45-degree field of view. 2352 by 1568 pixels — 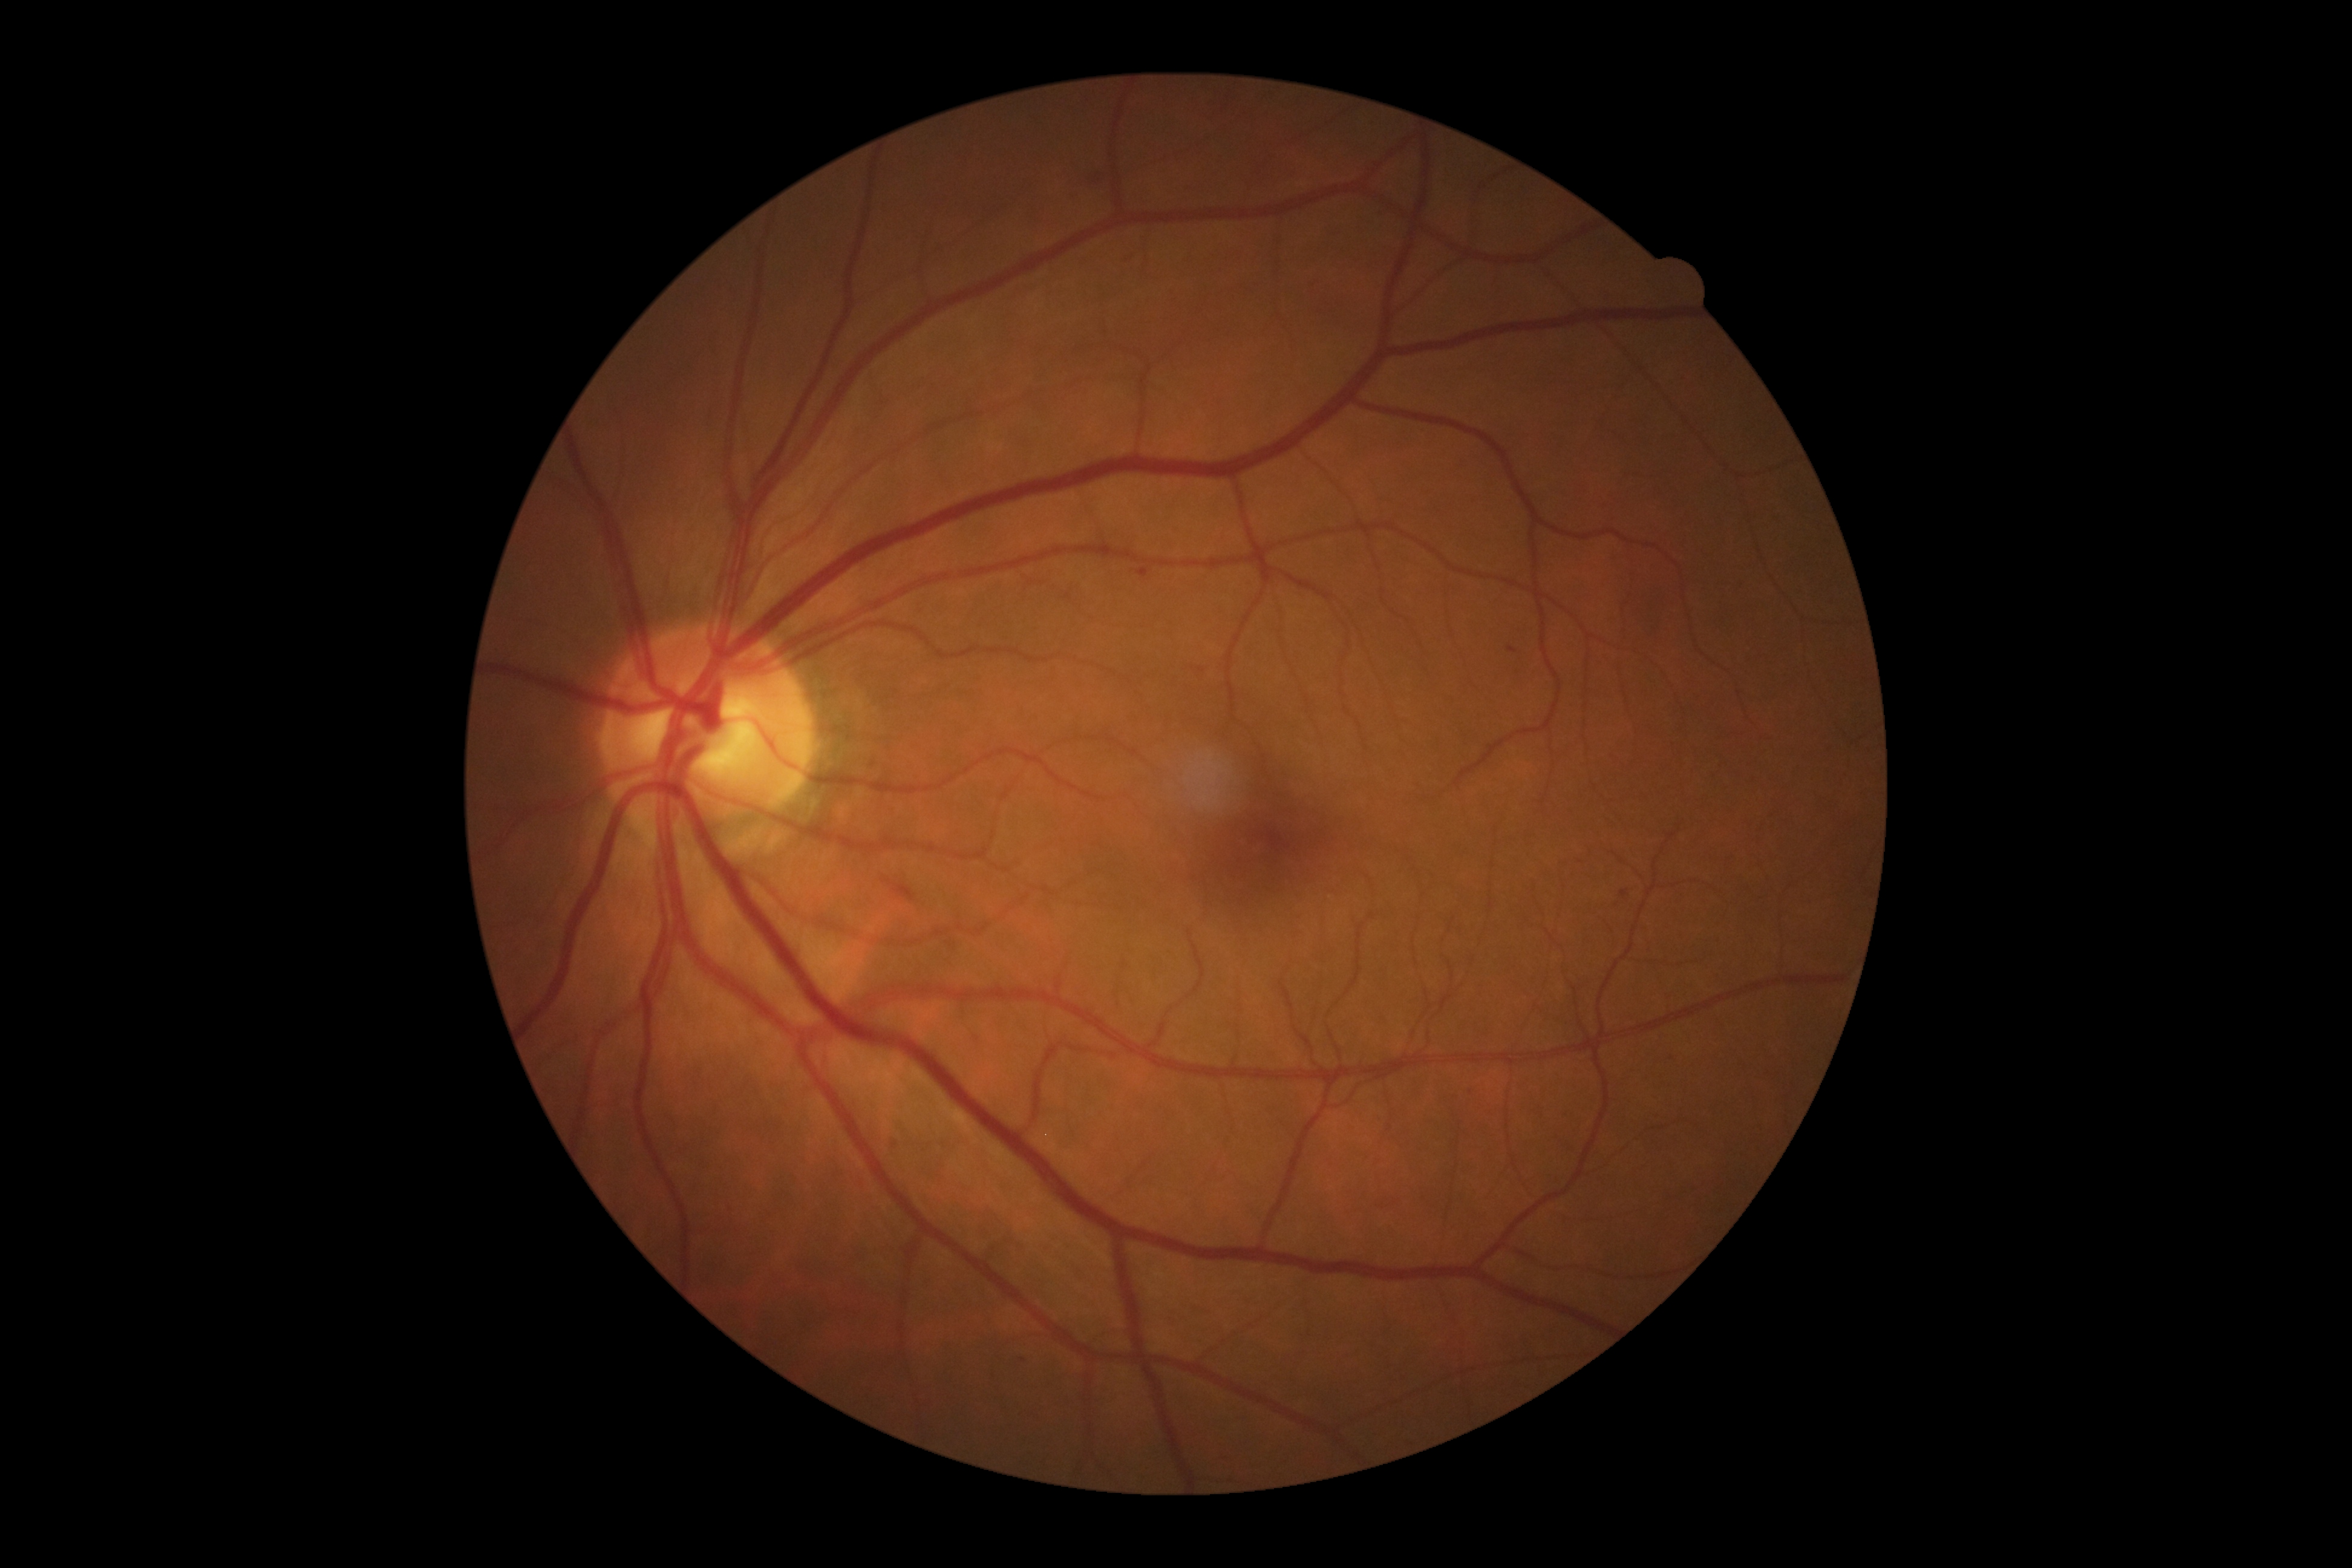

DR stage is grade 2 (moderate NPDR). MAs are present, including at <box>1091,170,1100,177</box>, <box>1621,890,1629,897</box>, <box>1508,647,1518,653</box>, <box>1138,567,1150,578</box>, <box>1068,192,1077,198</box>. Small MAs near pt(1024, 1360), pt(895, 1144). HEs at <box>884,878,916,902</box>. No EXs identified. No SEs identified.